2352 x 1568 pixels: 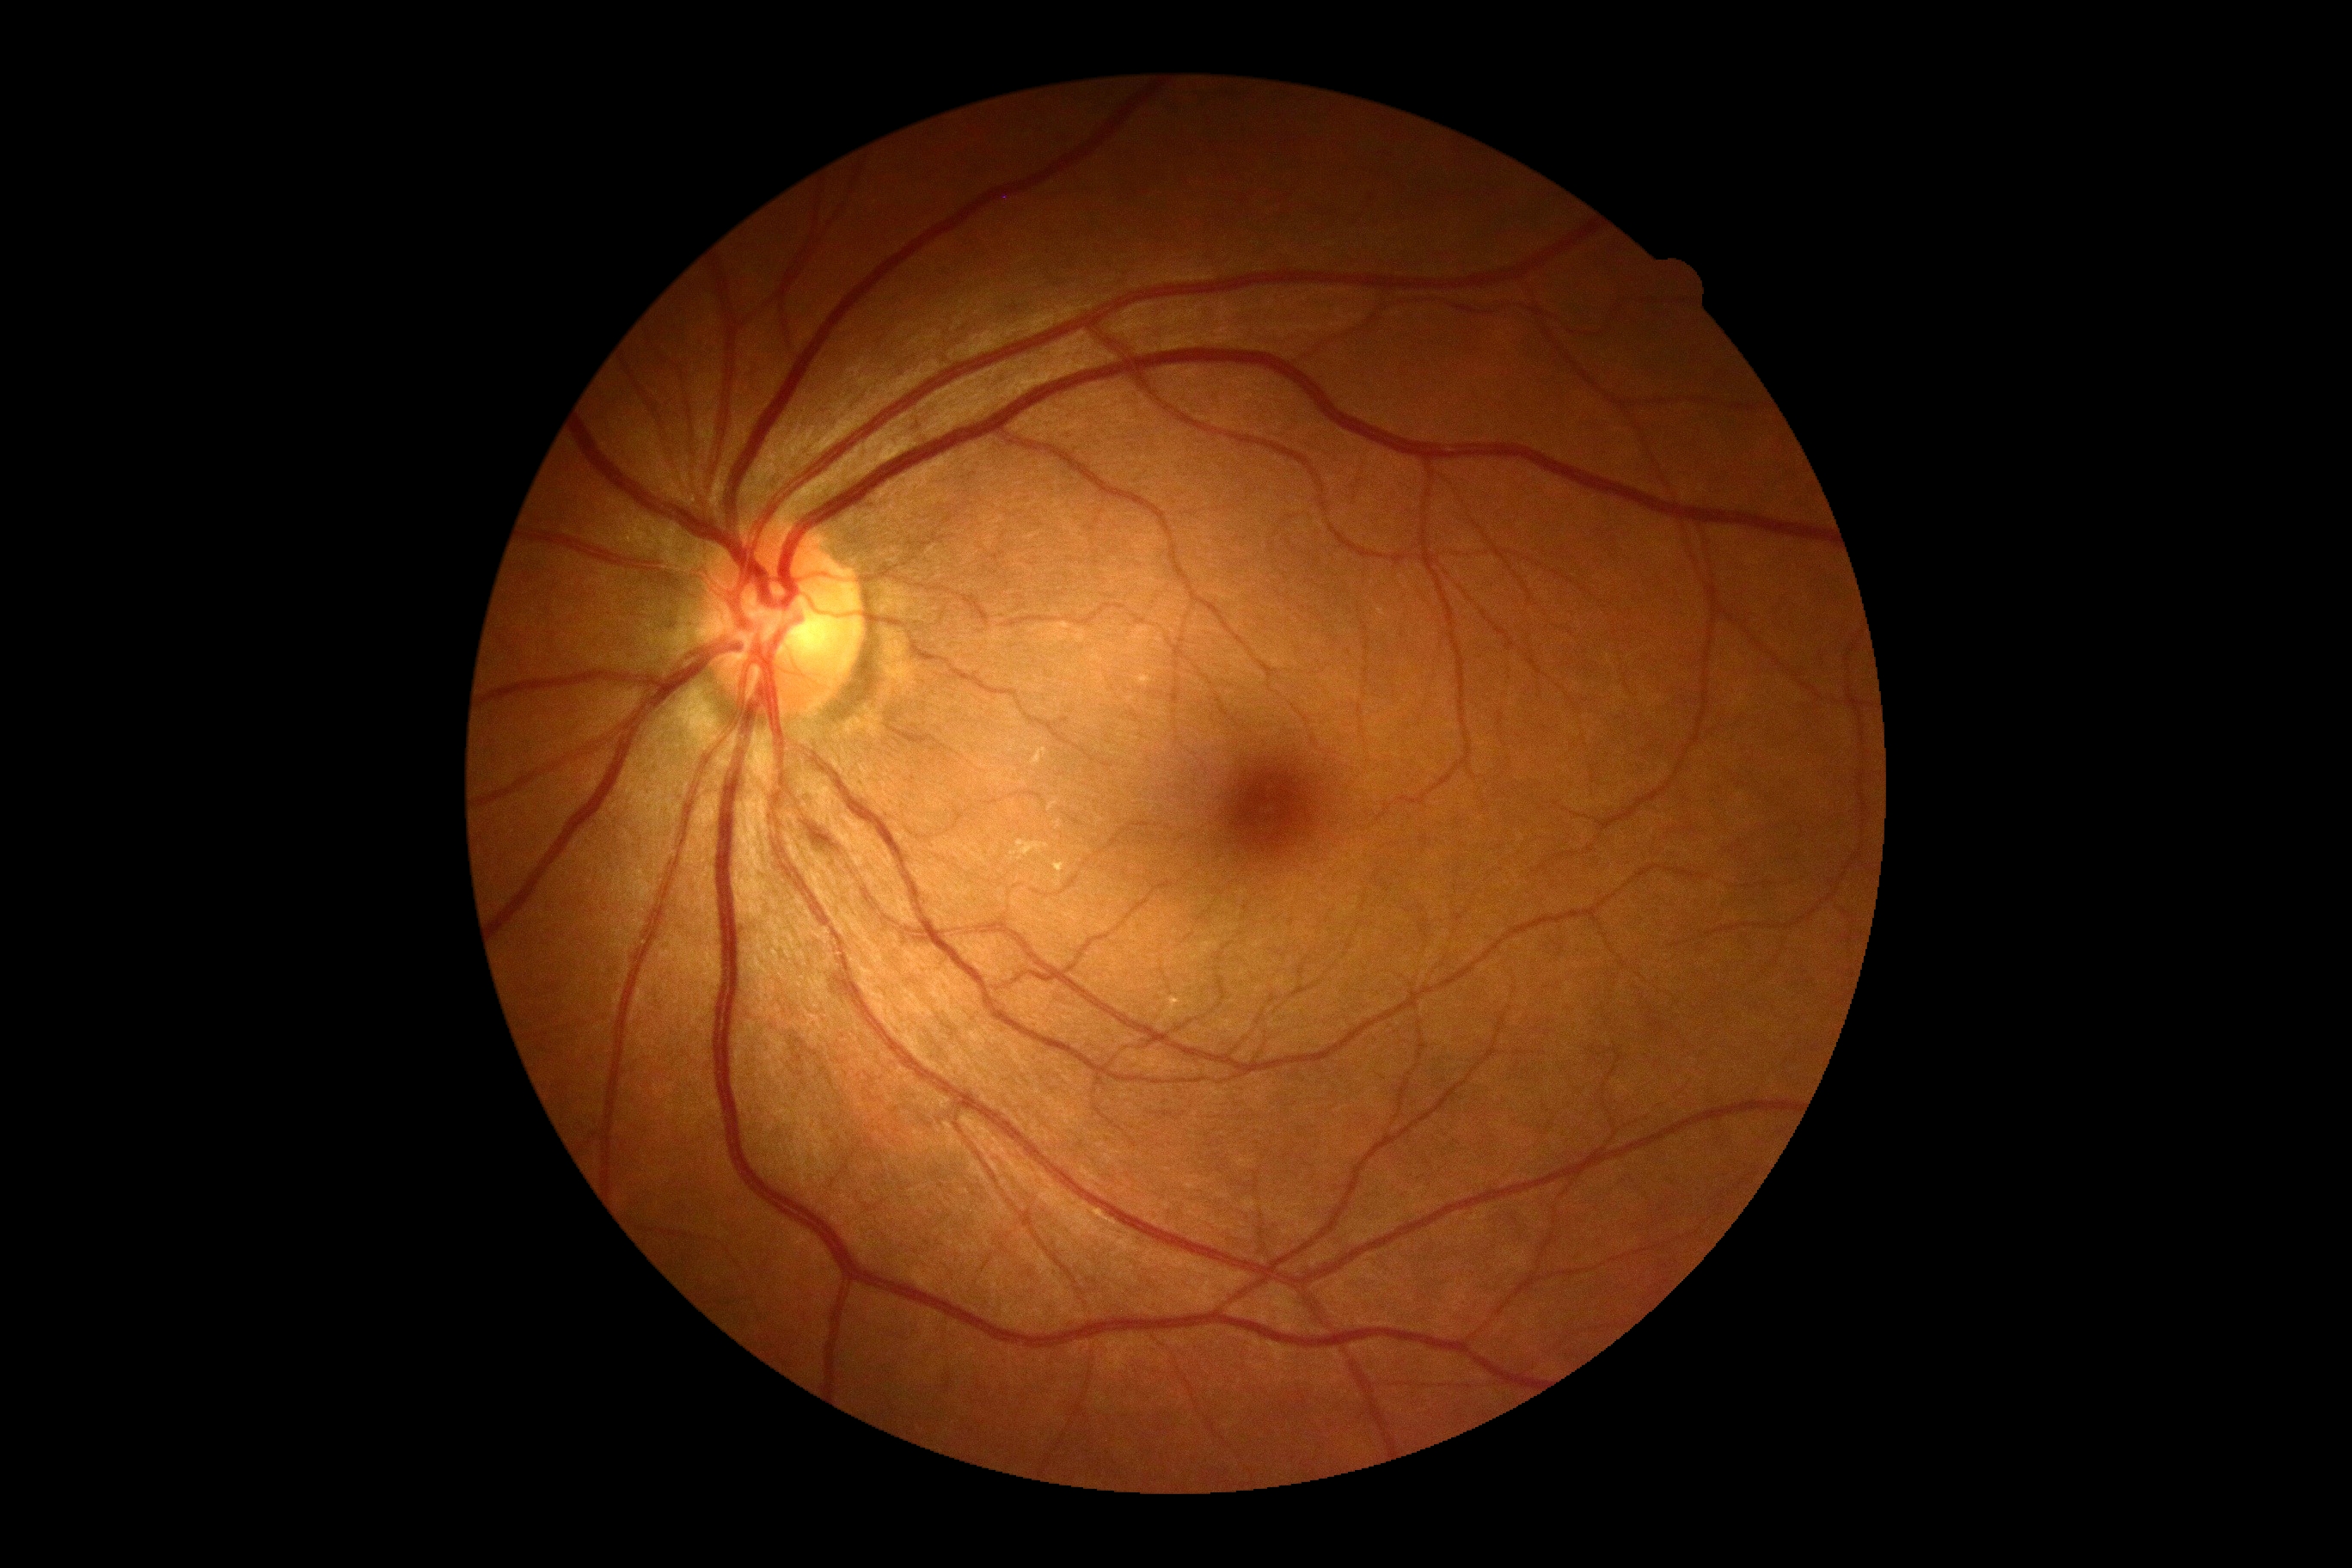 DR grade = no apparent retinopathy (0).